Acquired with a Nidek AFC-330.
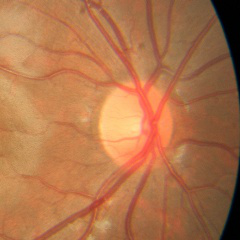

This fundus photograph shows no glaucomatous optic neuropathy.